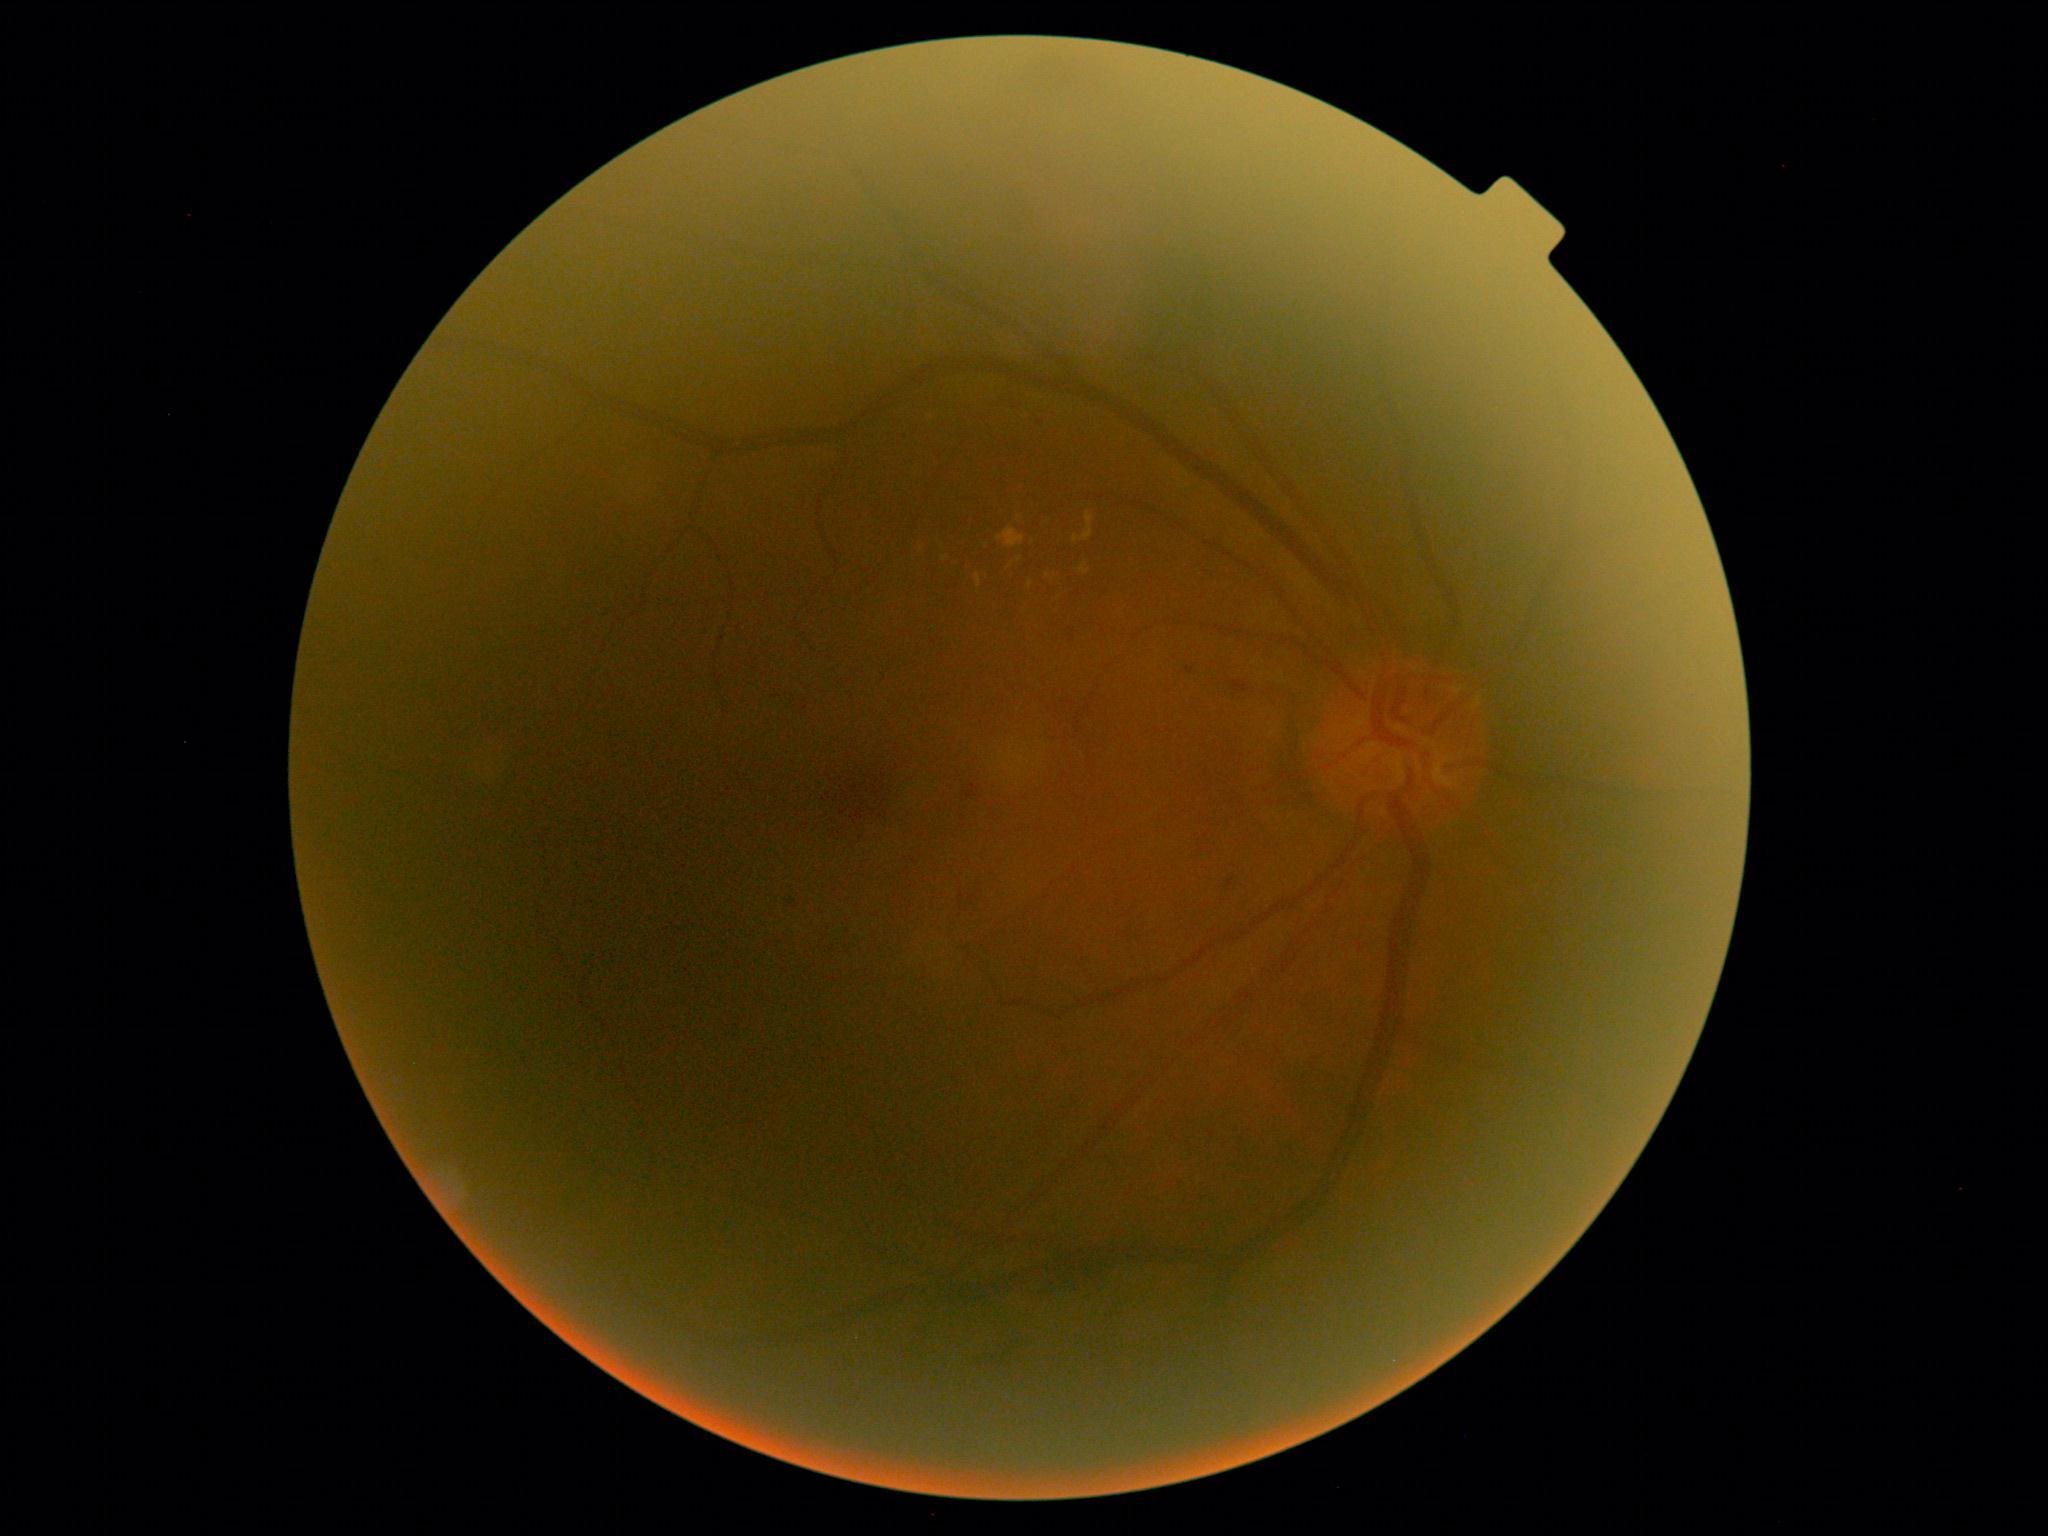 DR class@non-proliferative diabetic retinopathy; diabetic retinopathy (DR)@2.